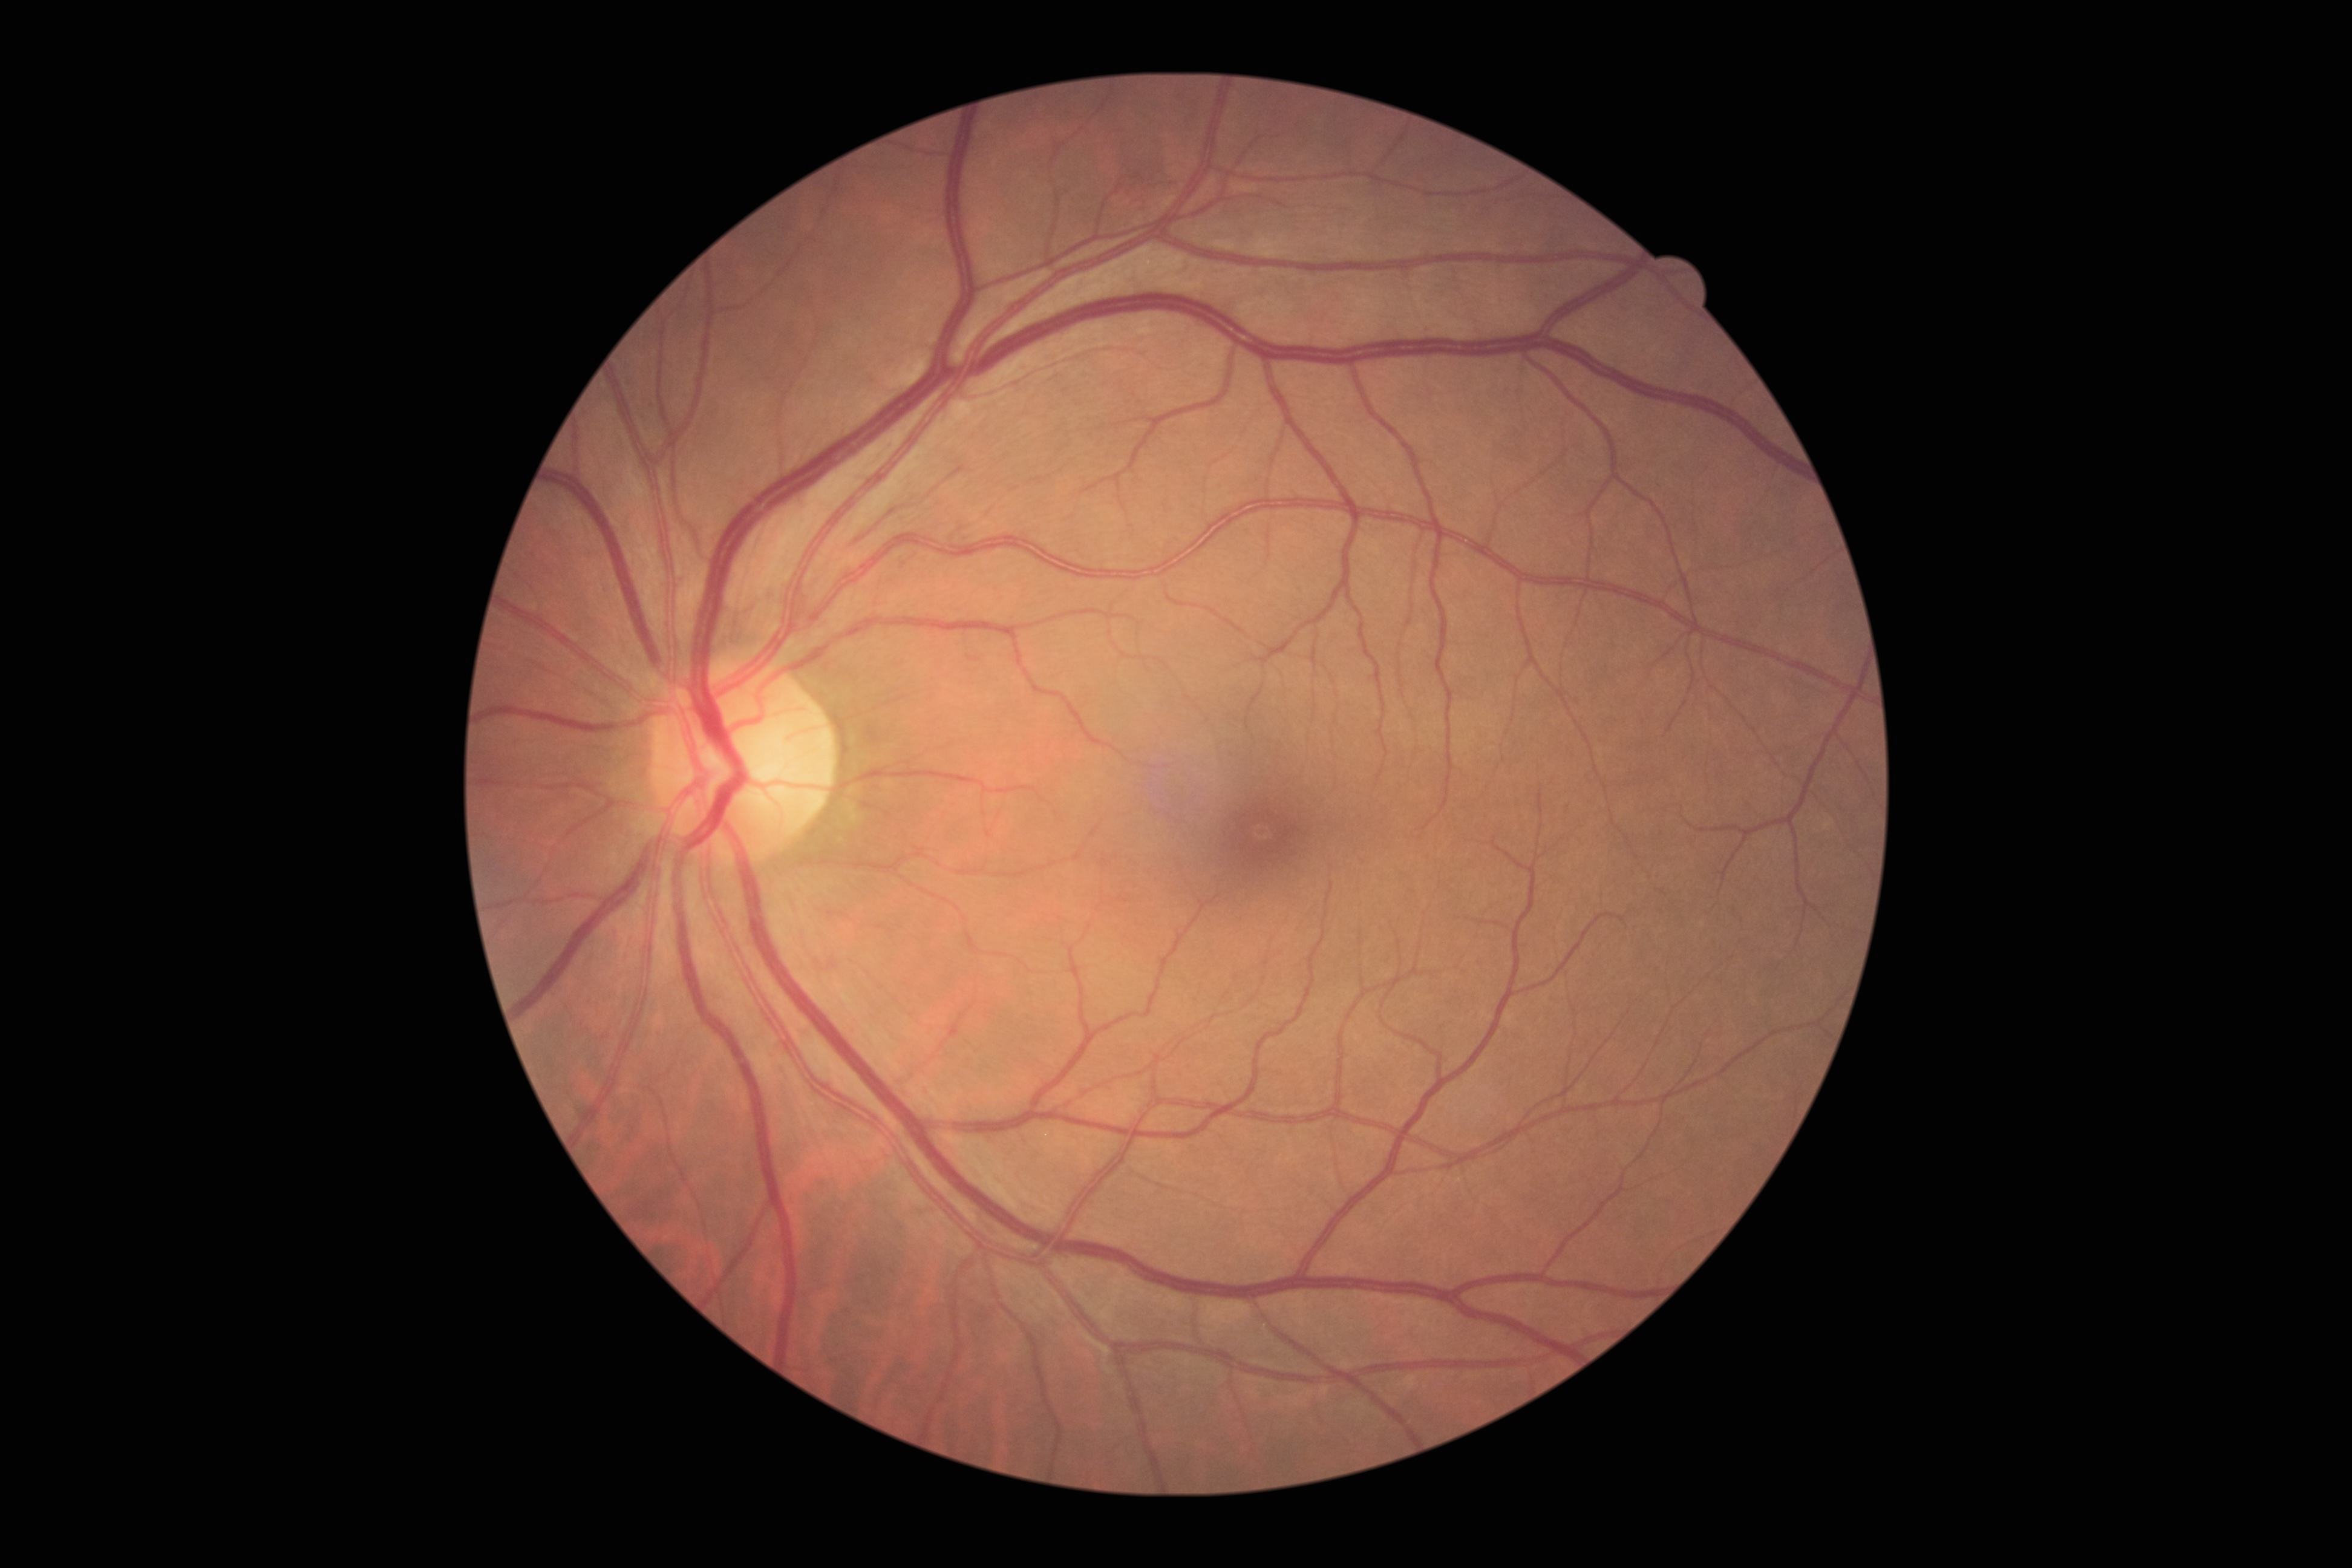

diabetic retinopathy: grade 2 (moderate NPDR).